Nonmydriatic; 45-degree field of view; color fundus image — 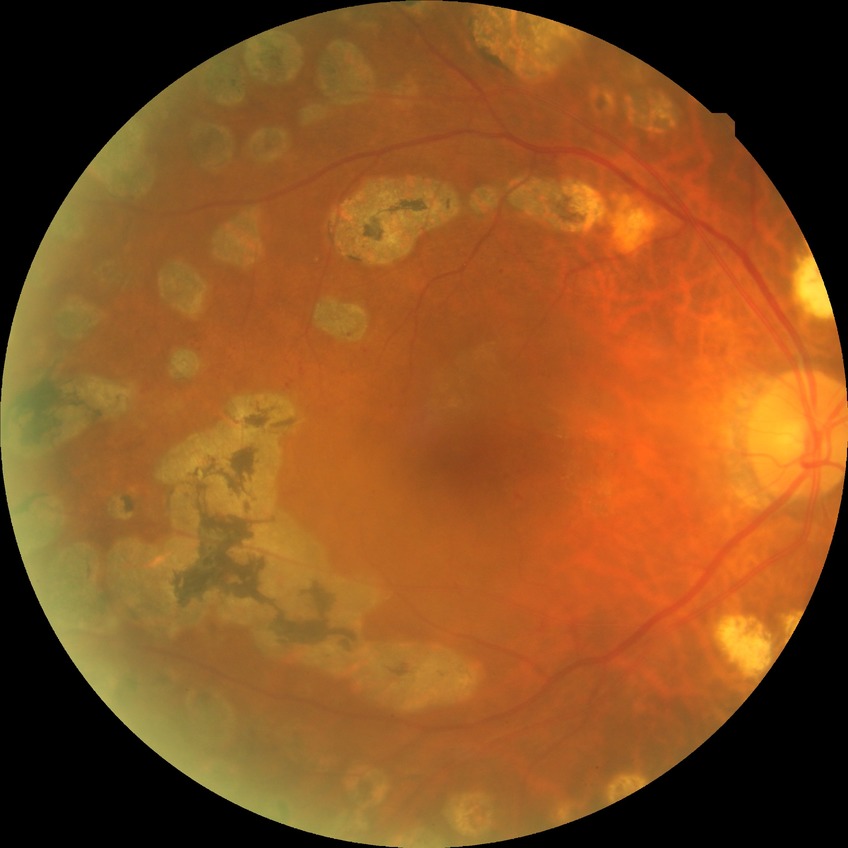
Annotations:
- diabetic retinopathy (DR): proliferative diabetic retinopathy (PDR)